ONH-centered crop from a color fundus image; 322x322px.
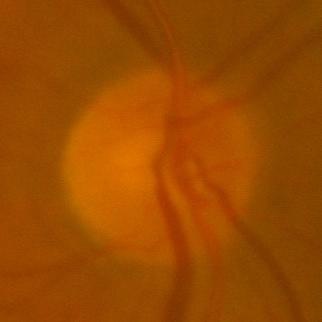

The image shows no glaucomatous changes.